50-degree field of view · dilated-pupil acquisition: 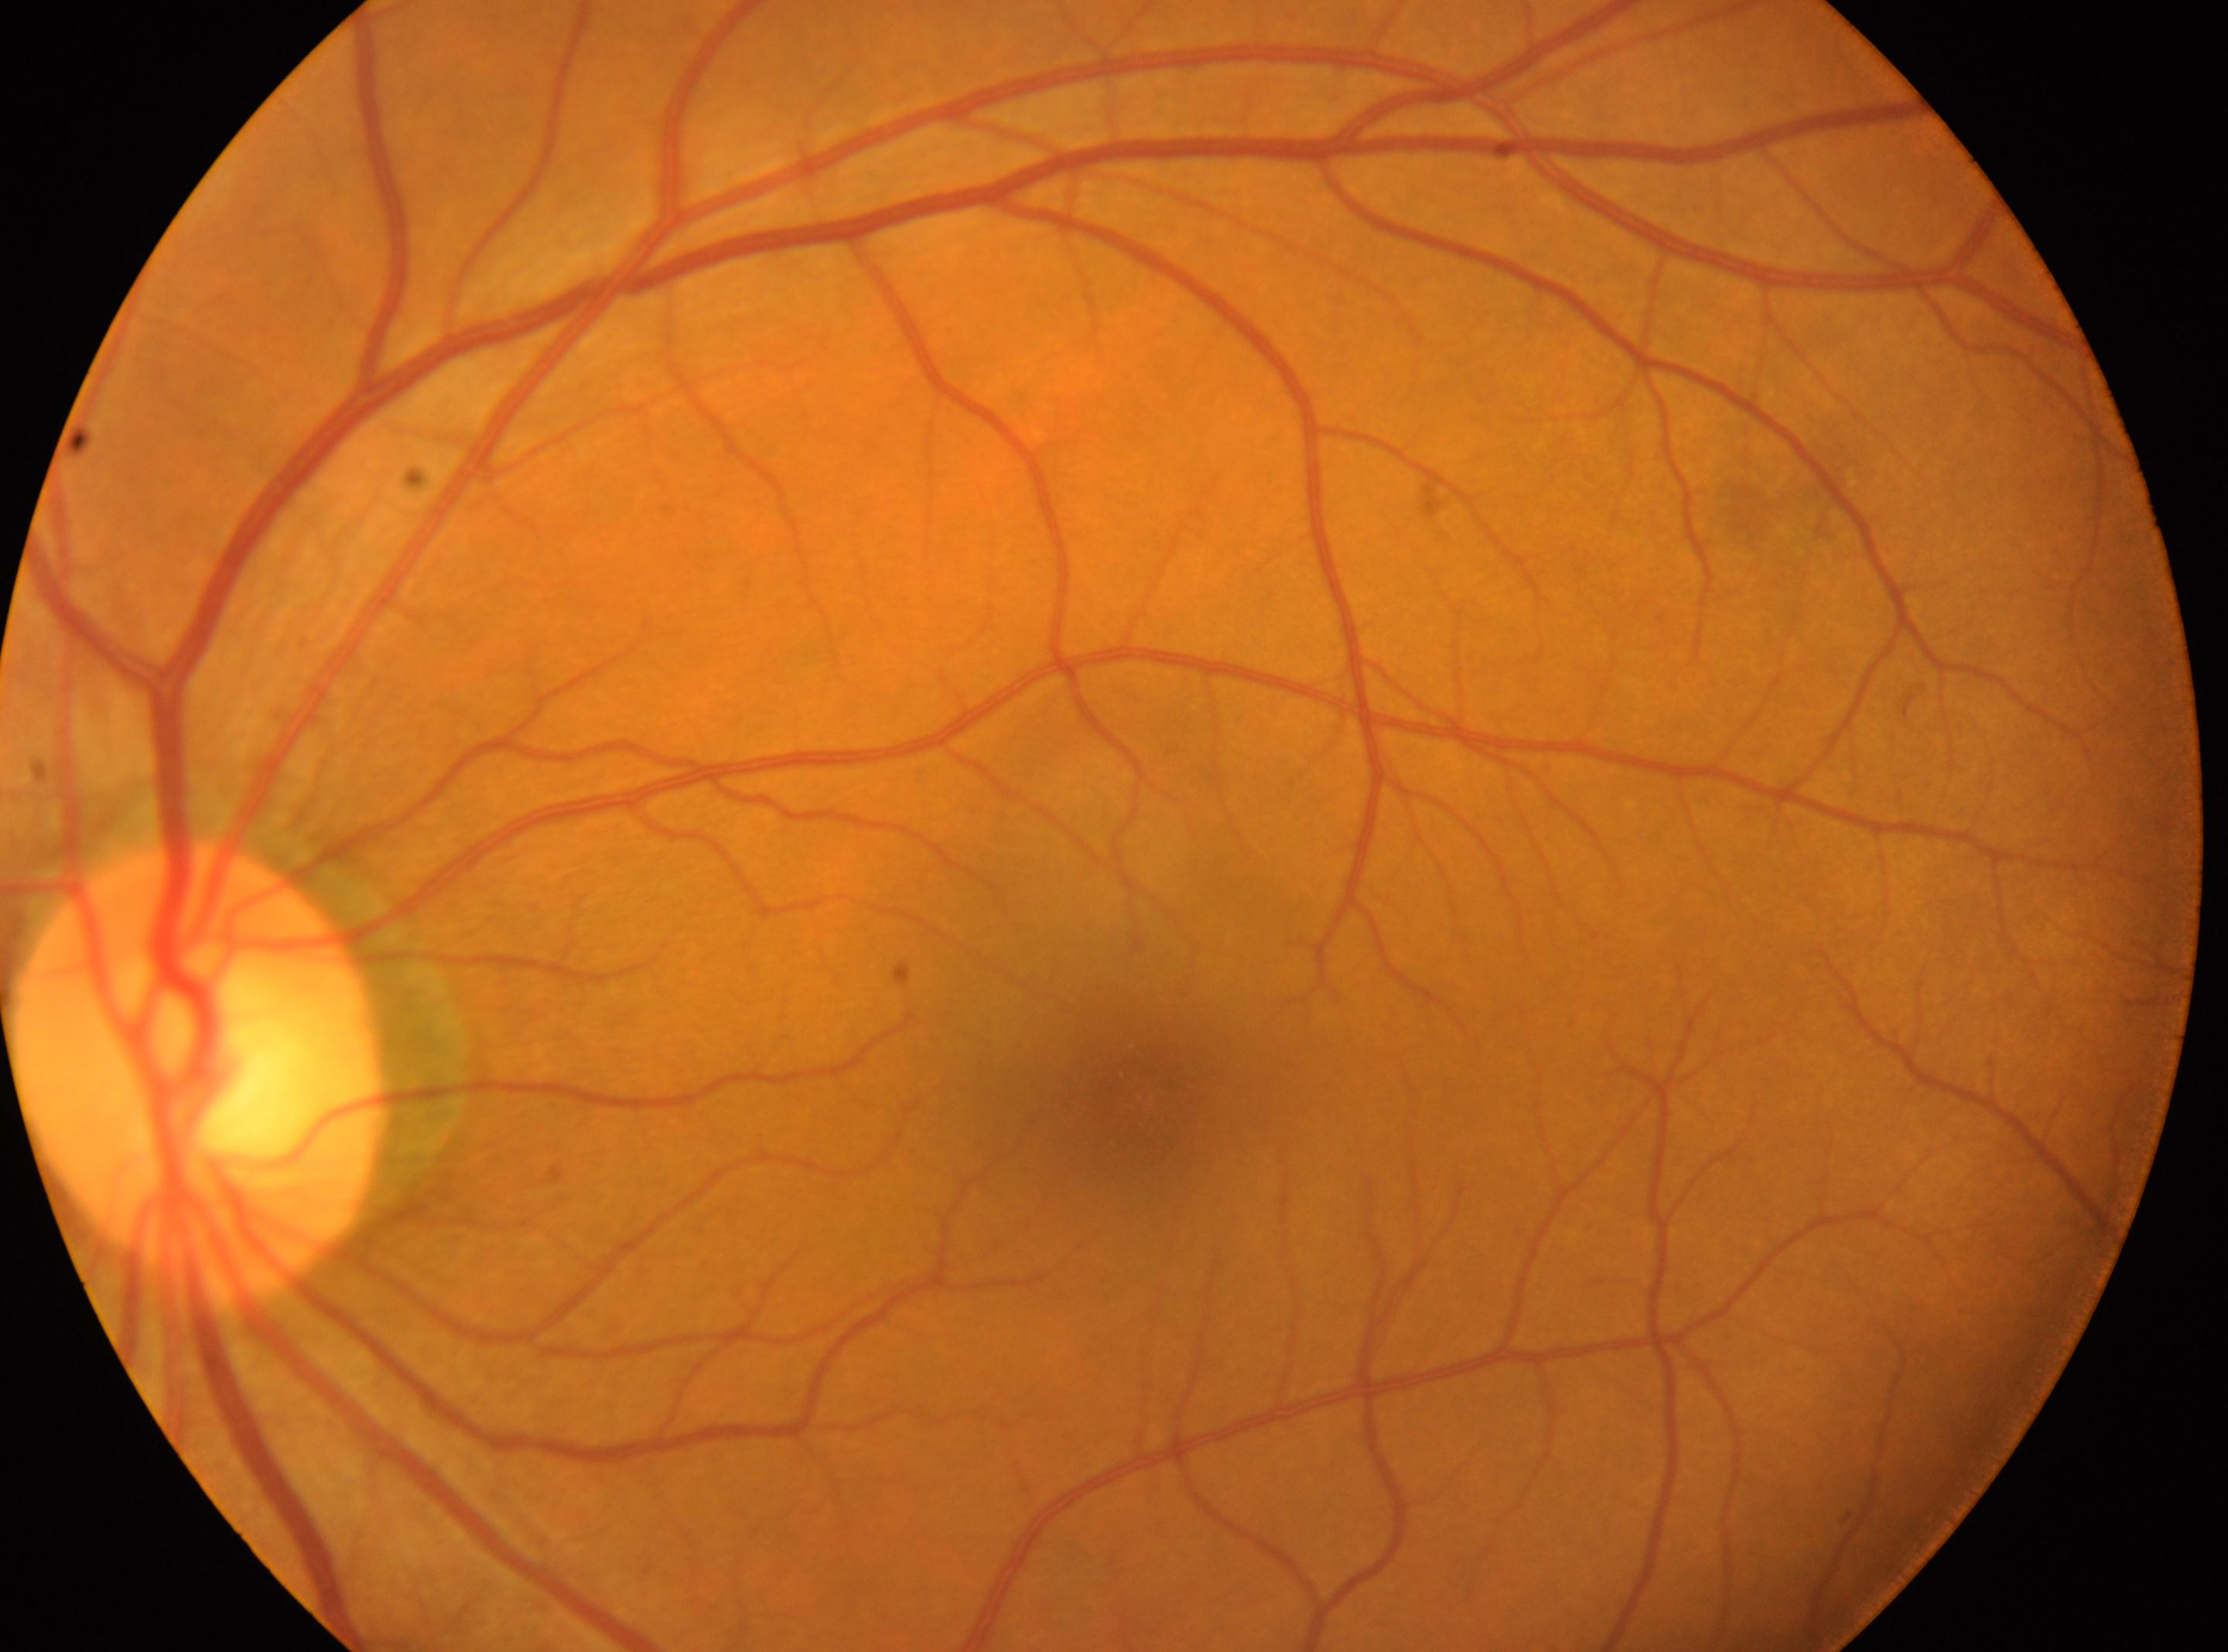 DR stage: no apparent retinopathy (grade 0) — no visible signs of diabetic retinopathy. Optic disk: (x=201, y=1073). The fovea is at (x=1128, y=1097). This is the OS.